Color fundus photograph:
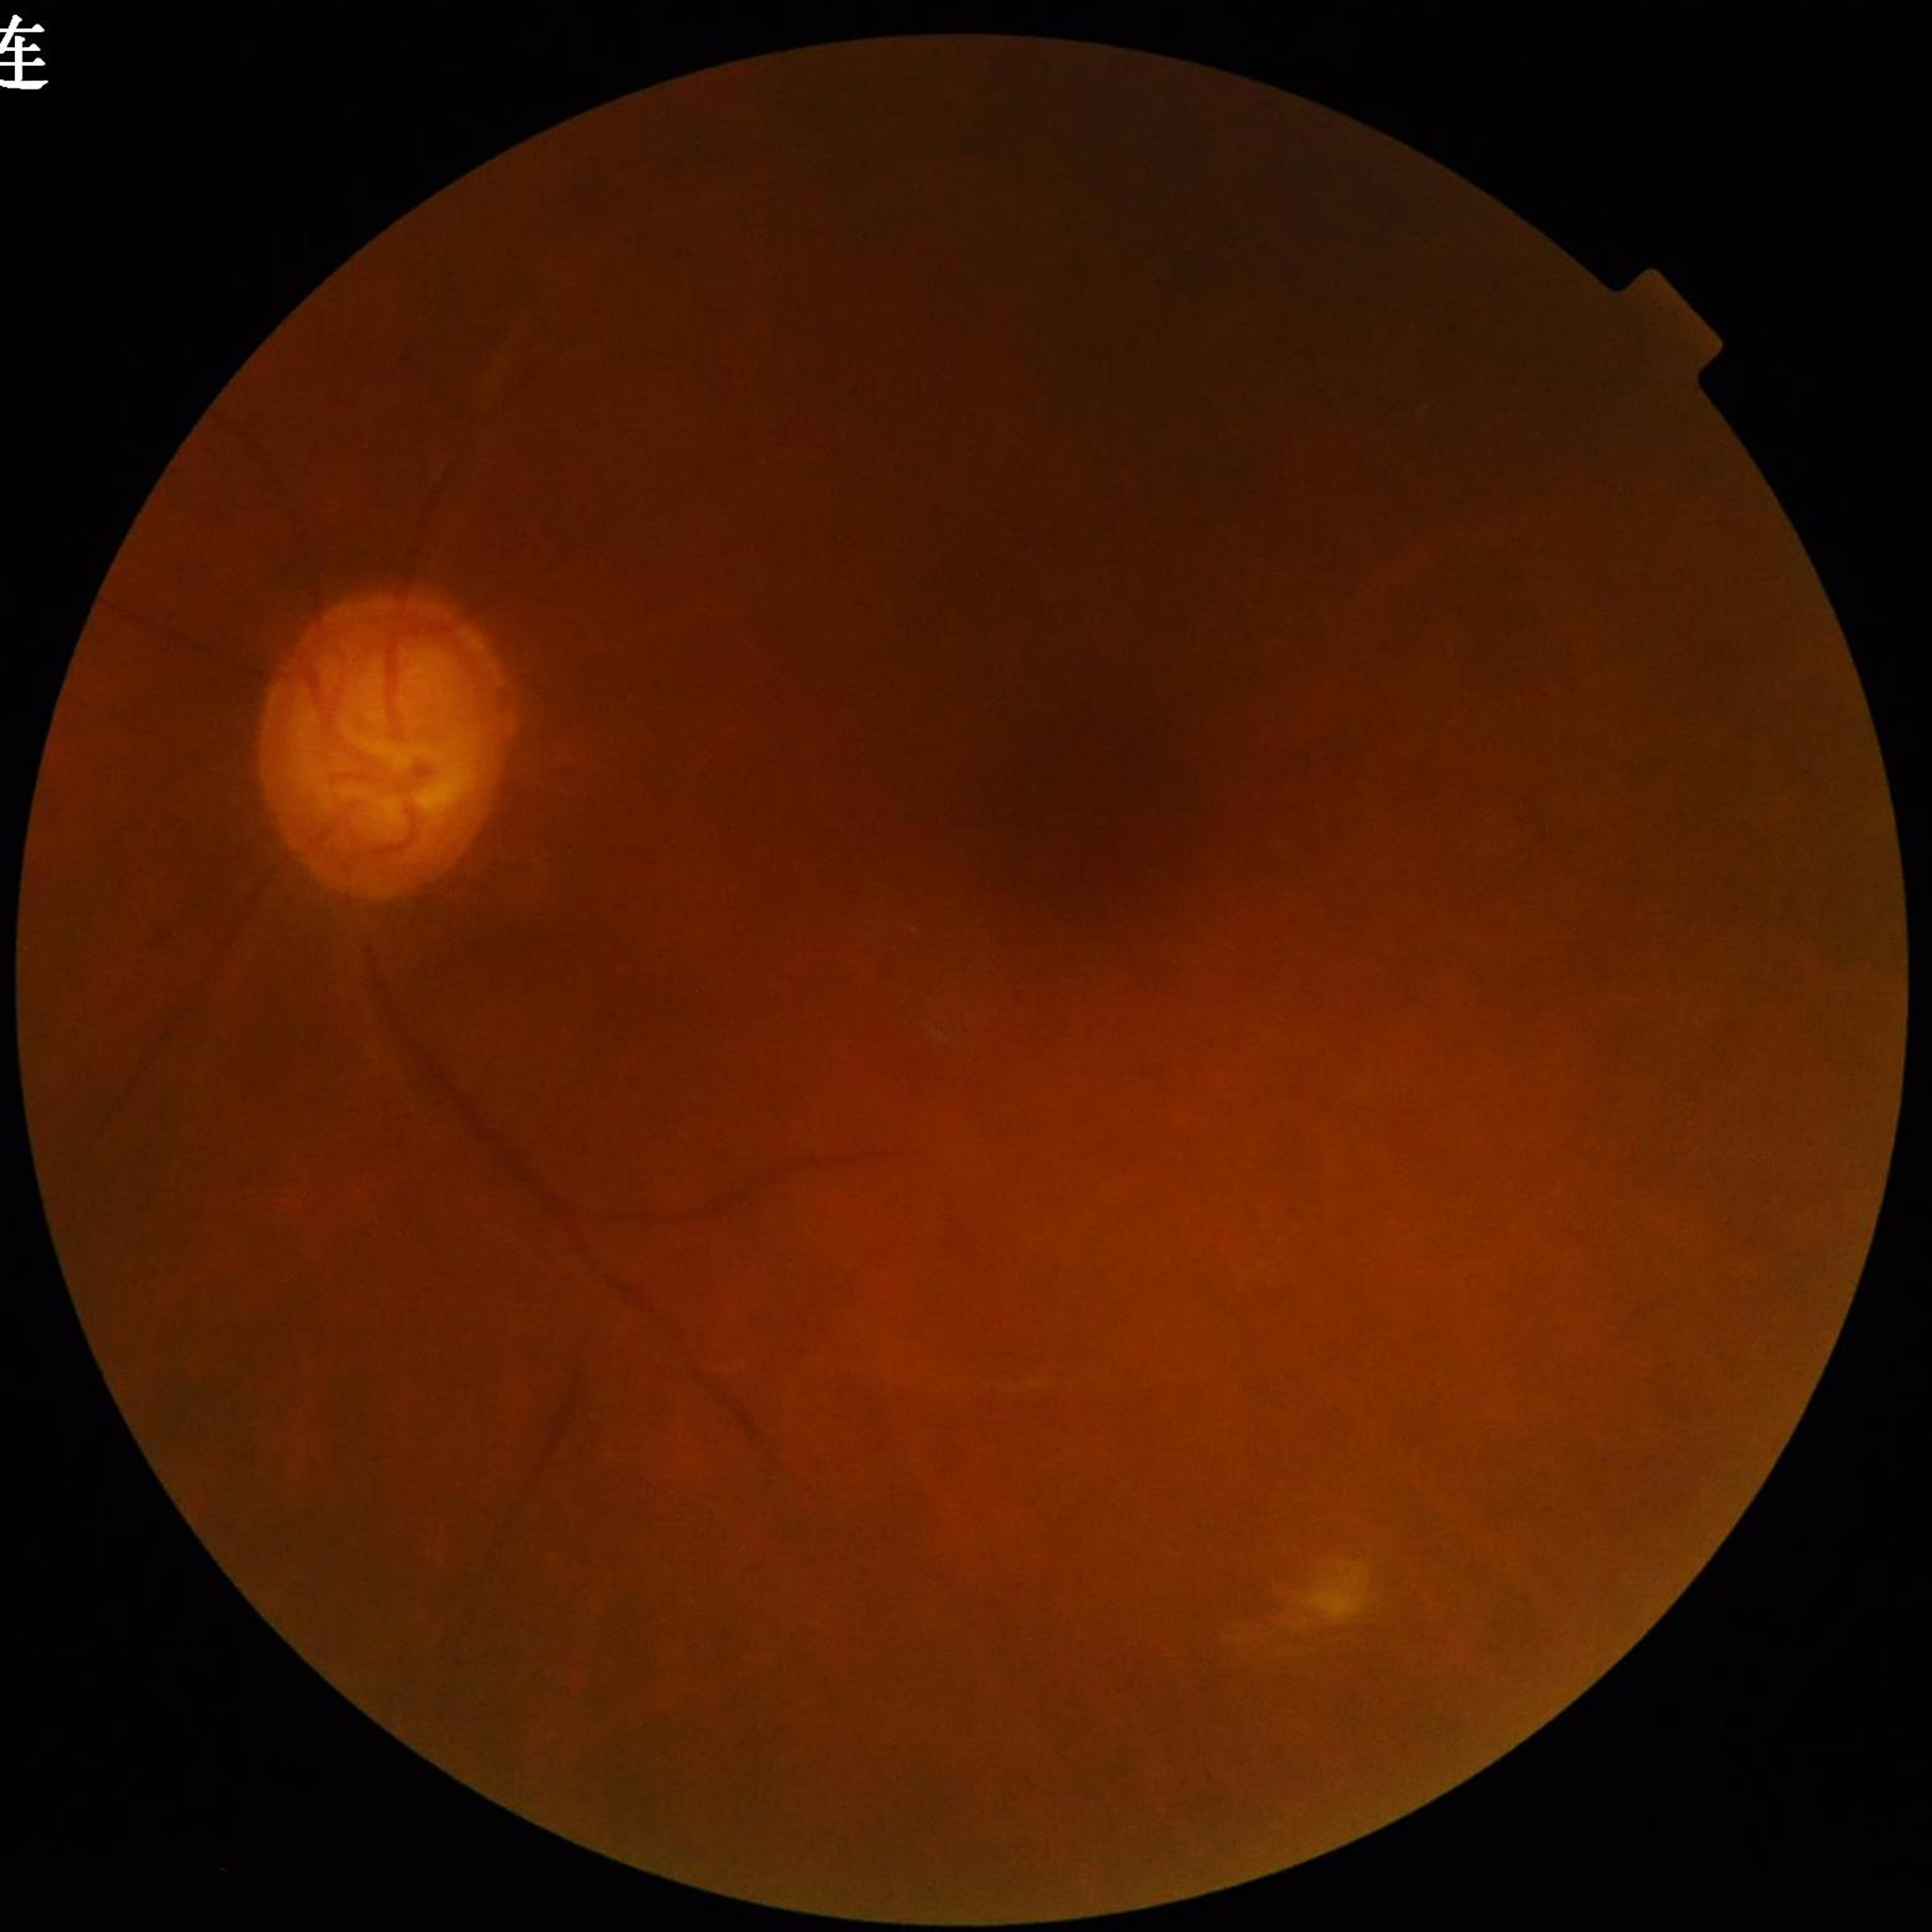 Diagnosis: glaucoma; Photo quality: illumination and color satisfactory, low contrast, blur present.